Wide-field fundus image from infant ROP screening; image size 640x480: 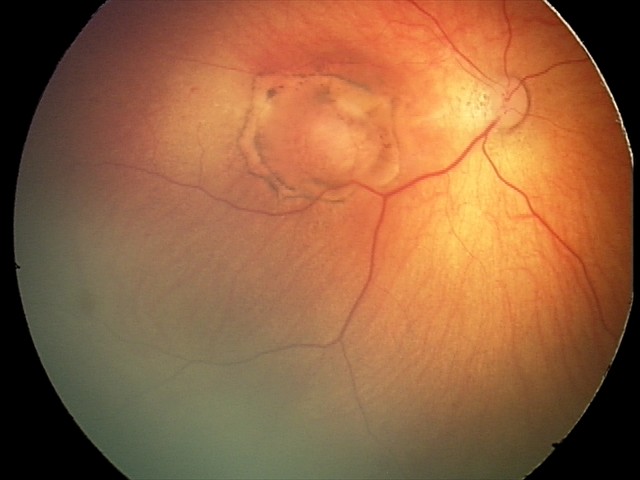

Examination diagnosed as toxoplasmosis chorioretinitis.